Color fundus image, captured on a Kowa VX-10α fundus camera, captured after pupil dilation, macula at the center of the field
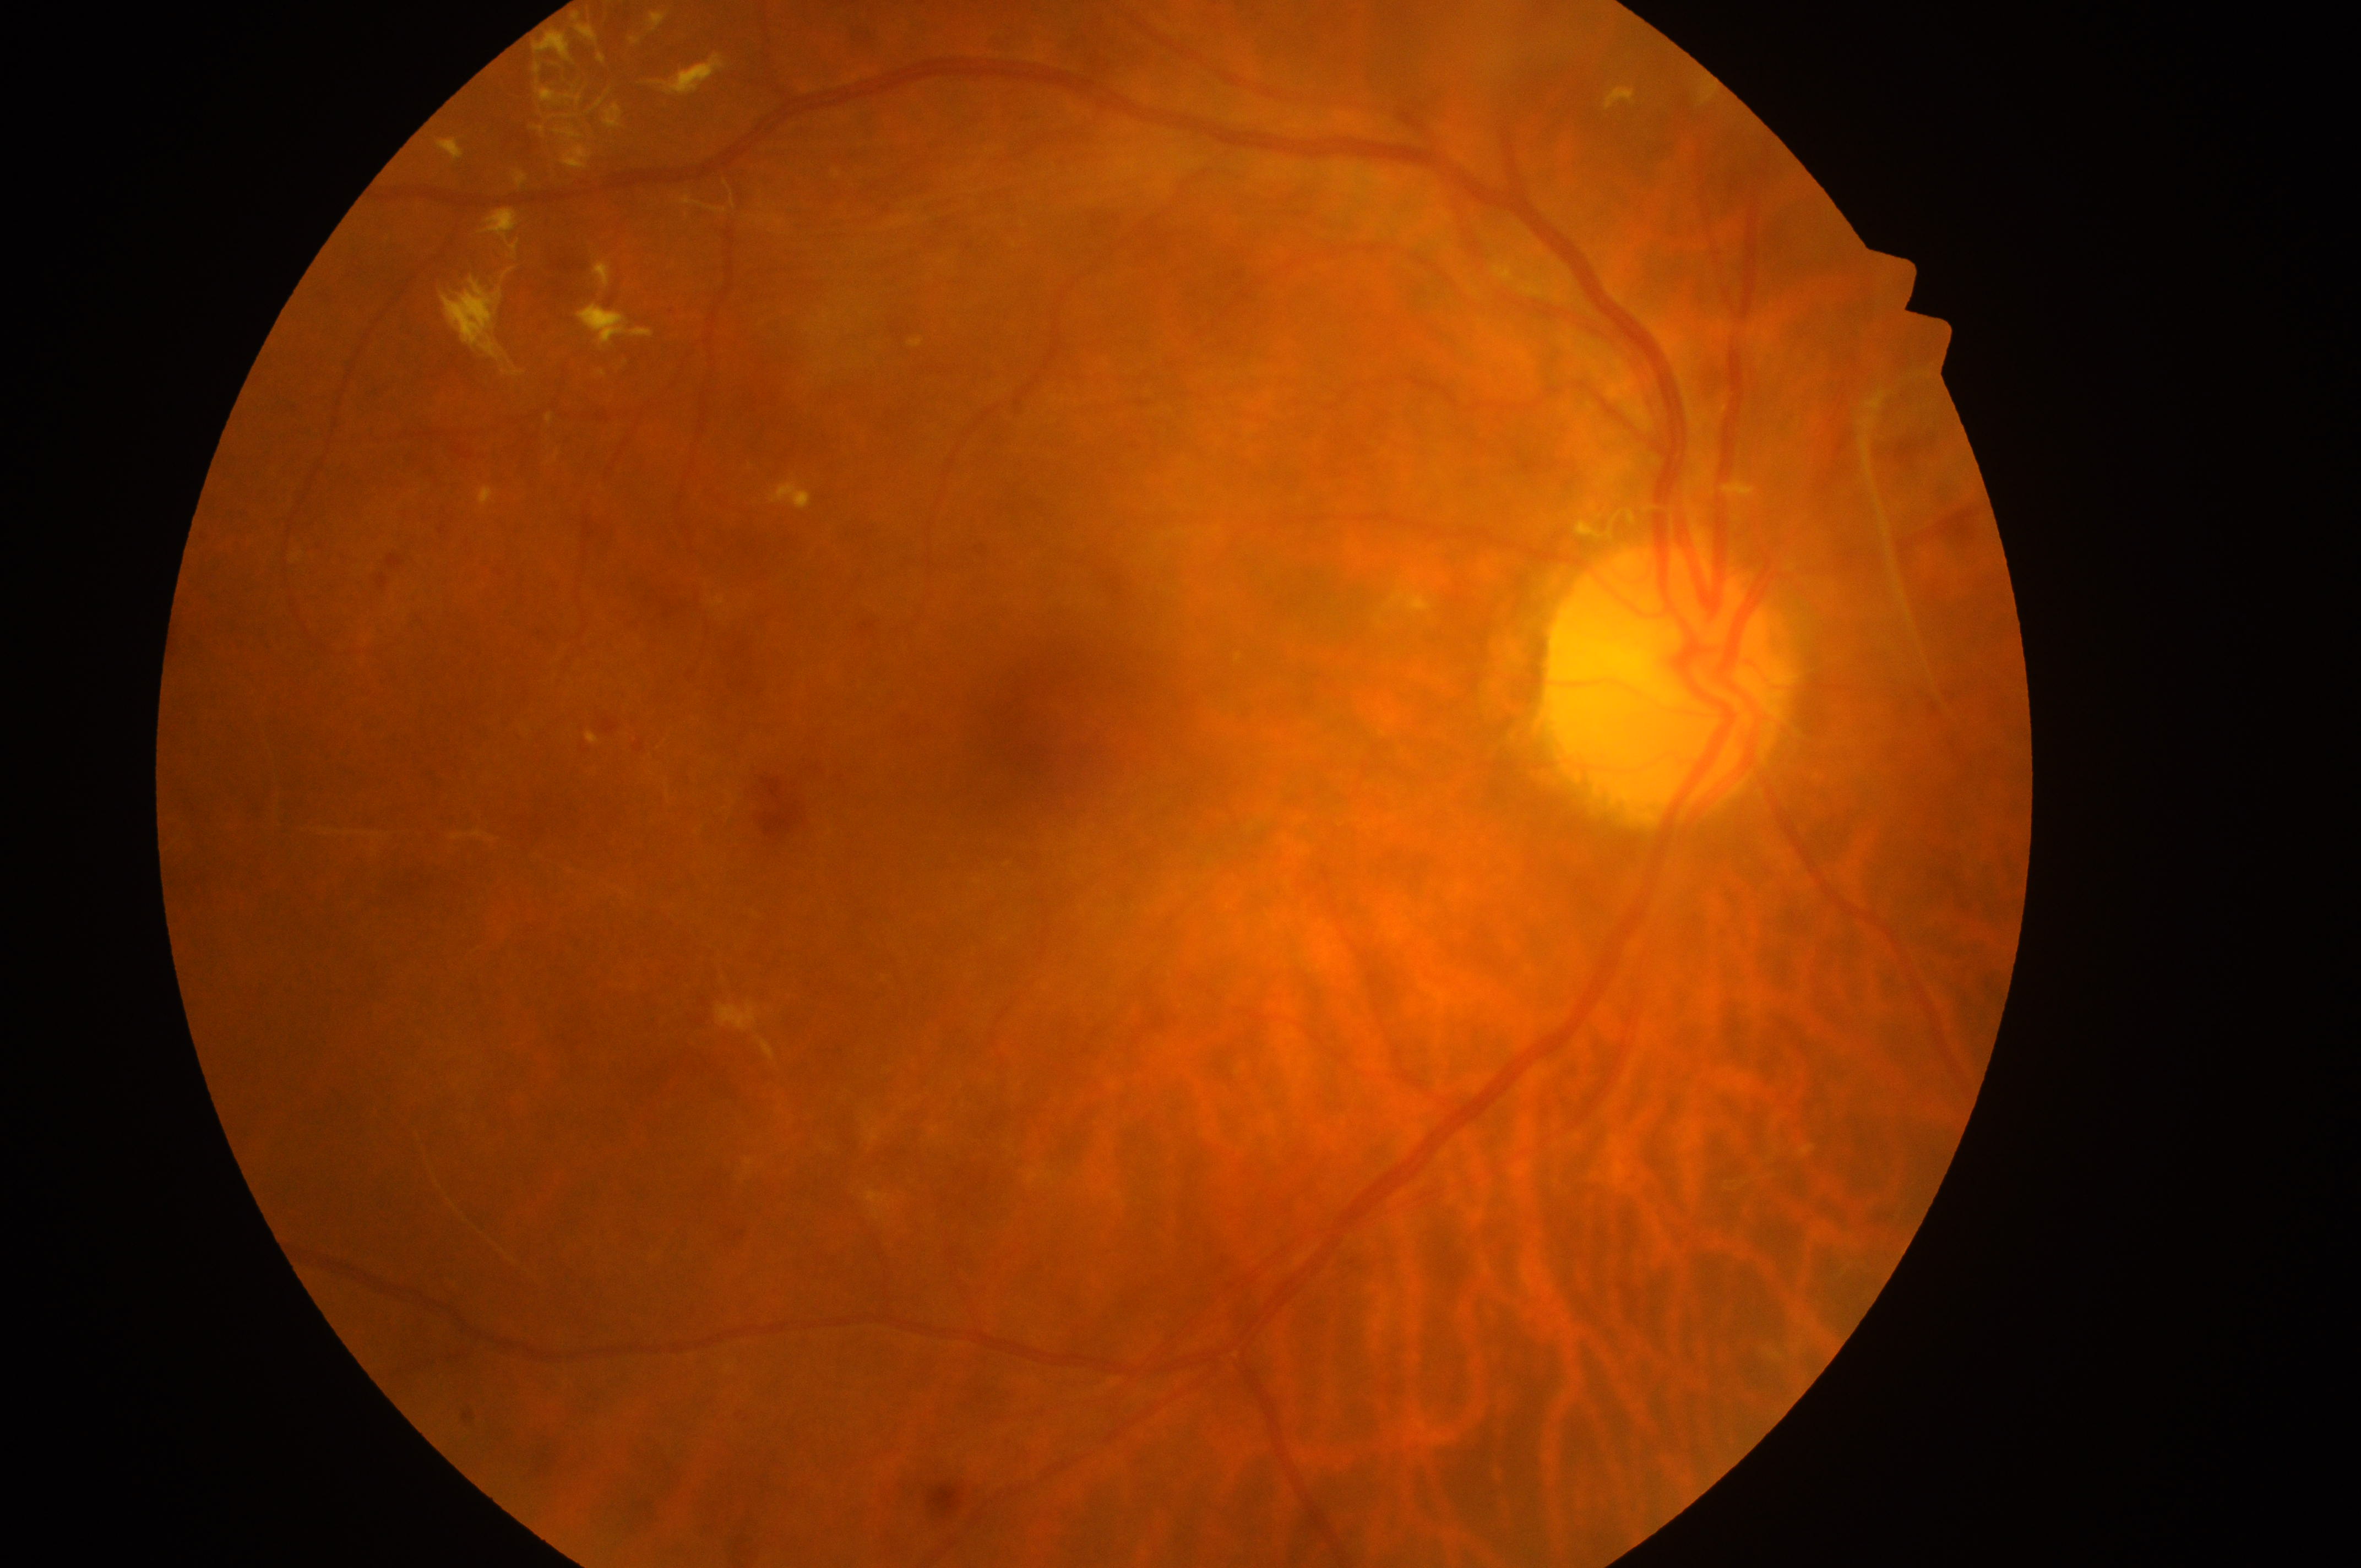

{"dr_grade": "4", "fovea": "1048px, 729px", "dme_grade": "2", "optic_disc": "1663px, 694px", "eye": "OD"}